45° field of view:
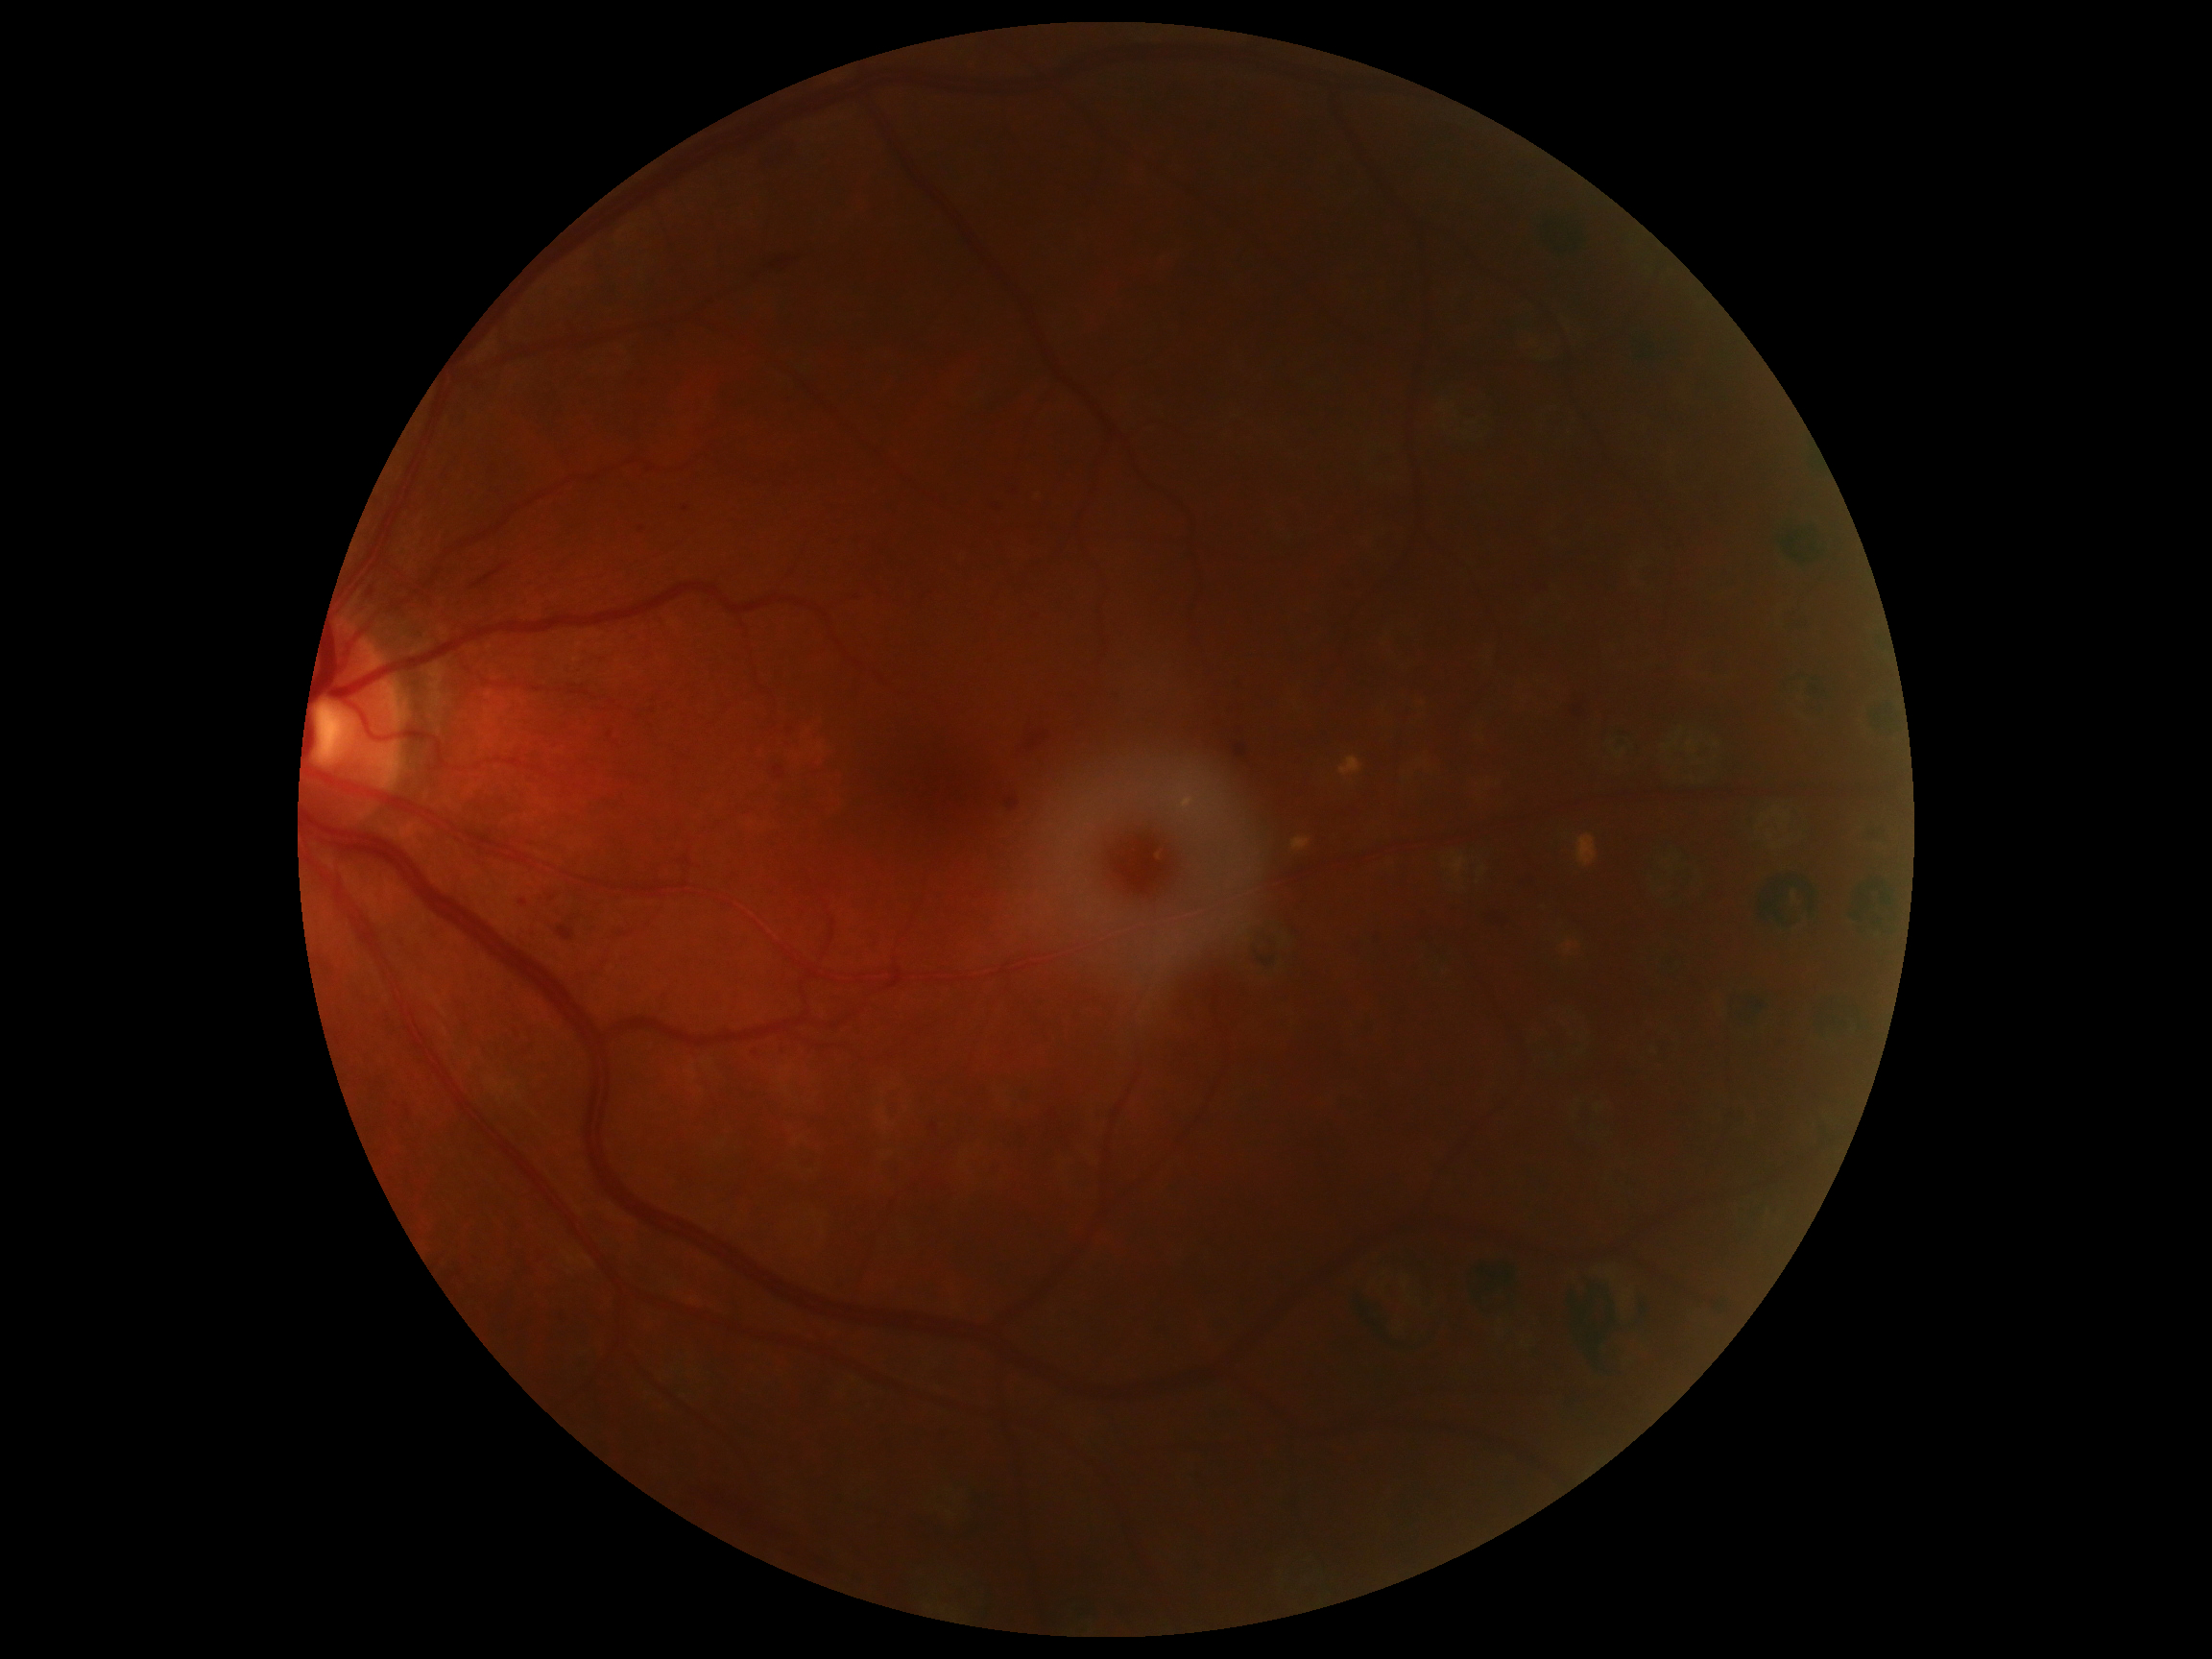

DR stage is moderate NPDR (grade 2).